45 degree fundus photograph, NIDEK AFC-230
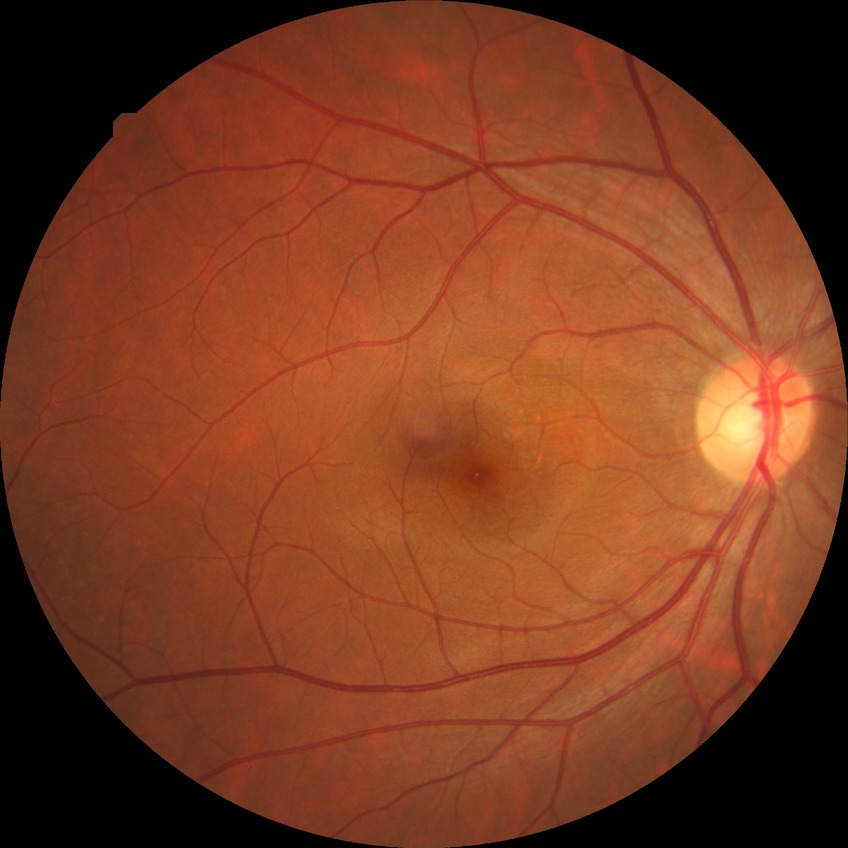 Retinopathy grade: simple diabetic retinopathy.